Pediatric wide-field fundus photograph — 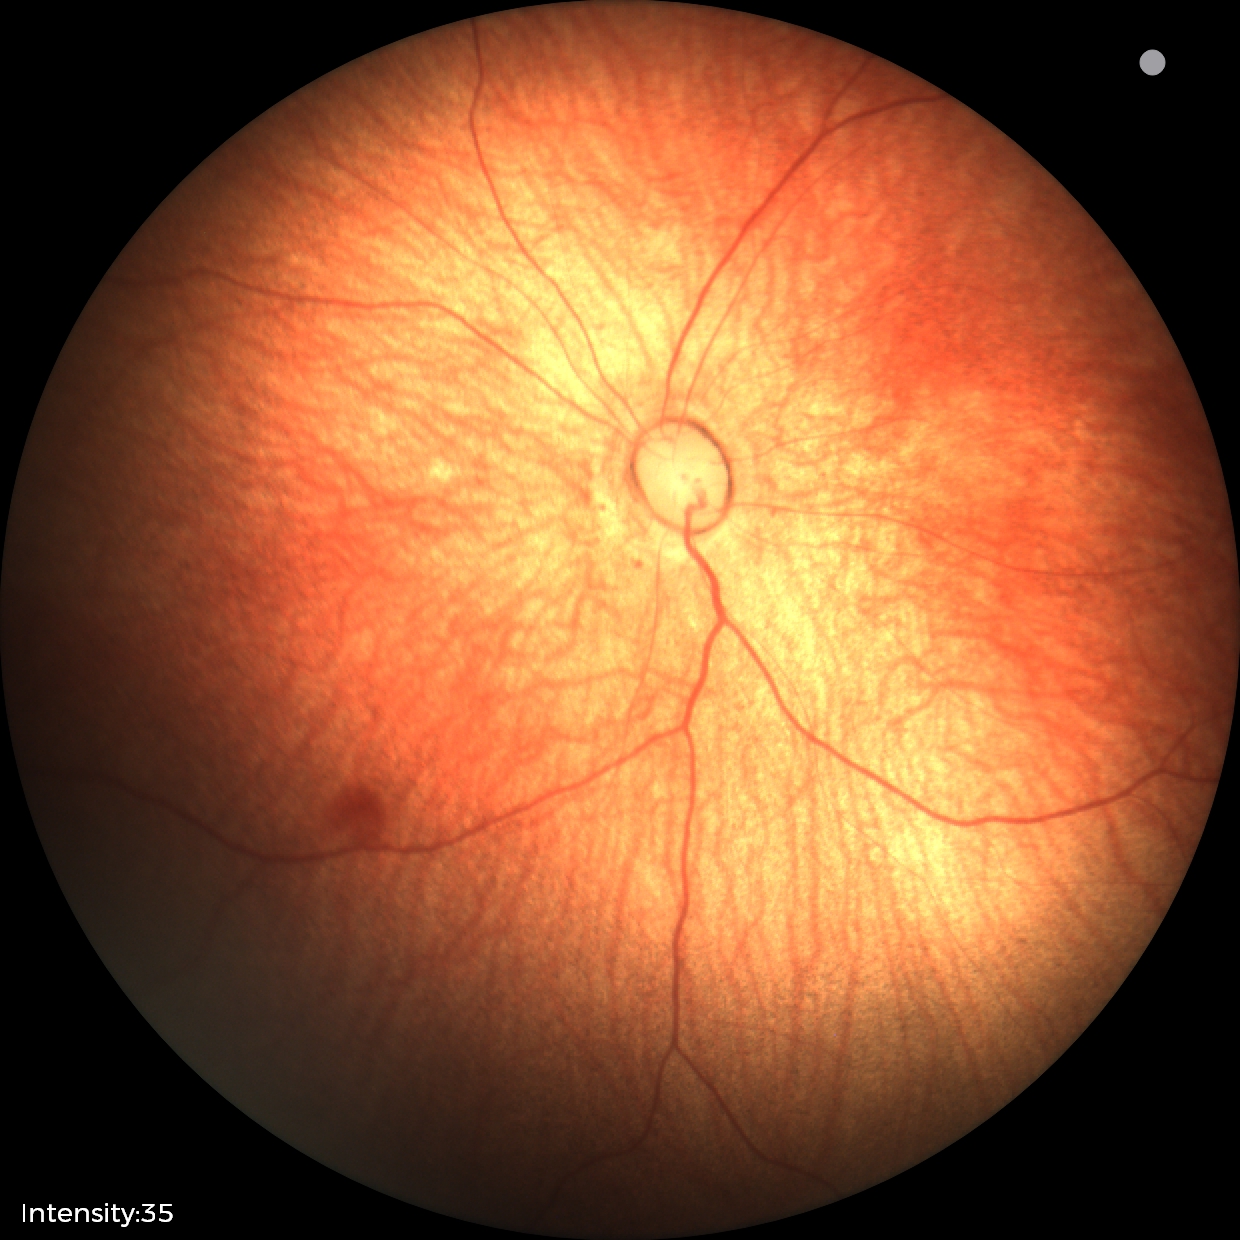

Examination with physiological retinal findings.